Image size 640x480; infant wide-field fundus photograph: 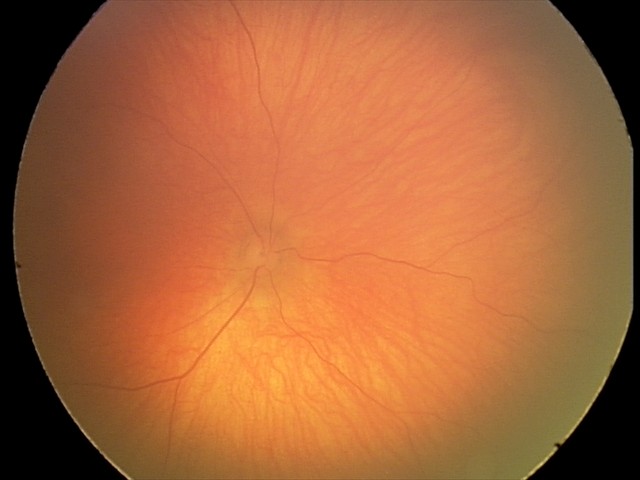

Physiological retinal appearance for postconceptual age.